Nonmydriatic, NIDEK AFC-230, 848x848px, DR severity per modified Davis staging, 45° field of view, posterior pole photograph
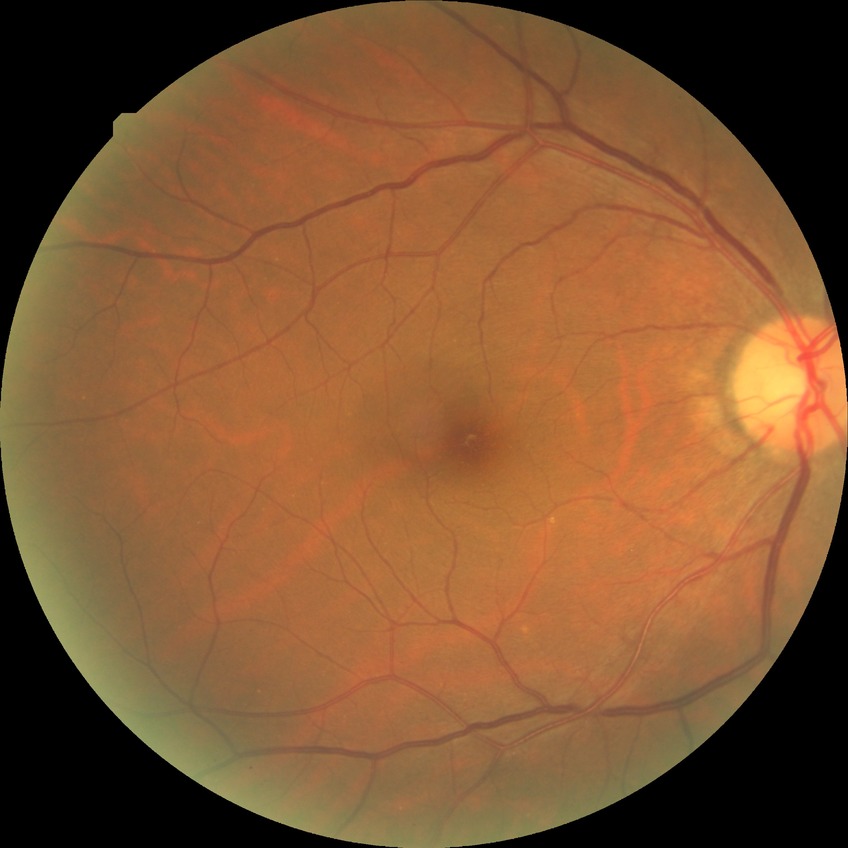
Diabetic retinopathy (DR) is NDR (no diabetic retinopathy).